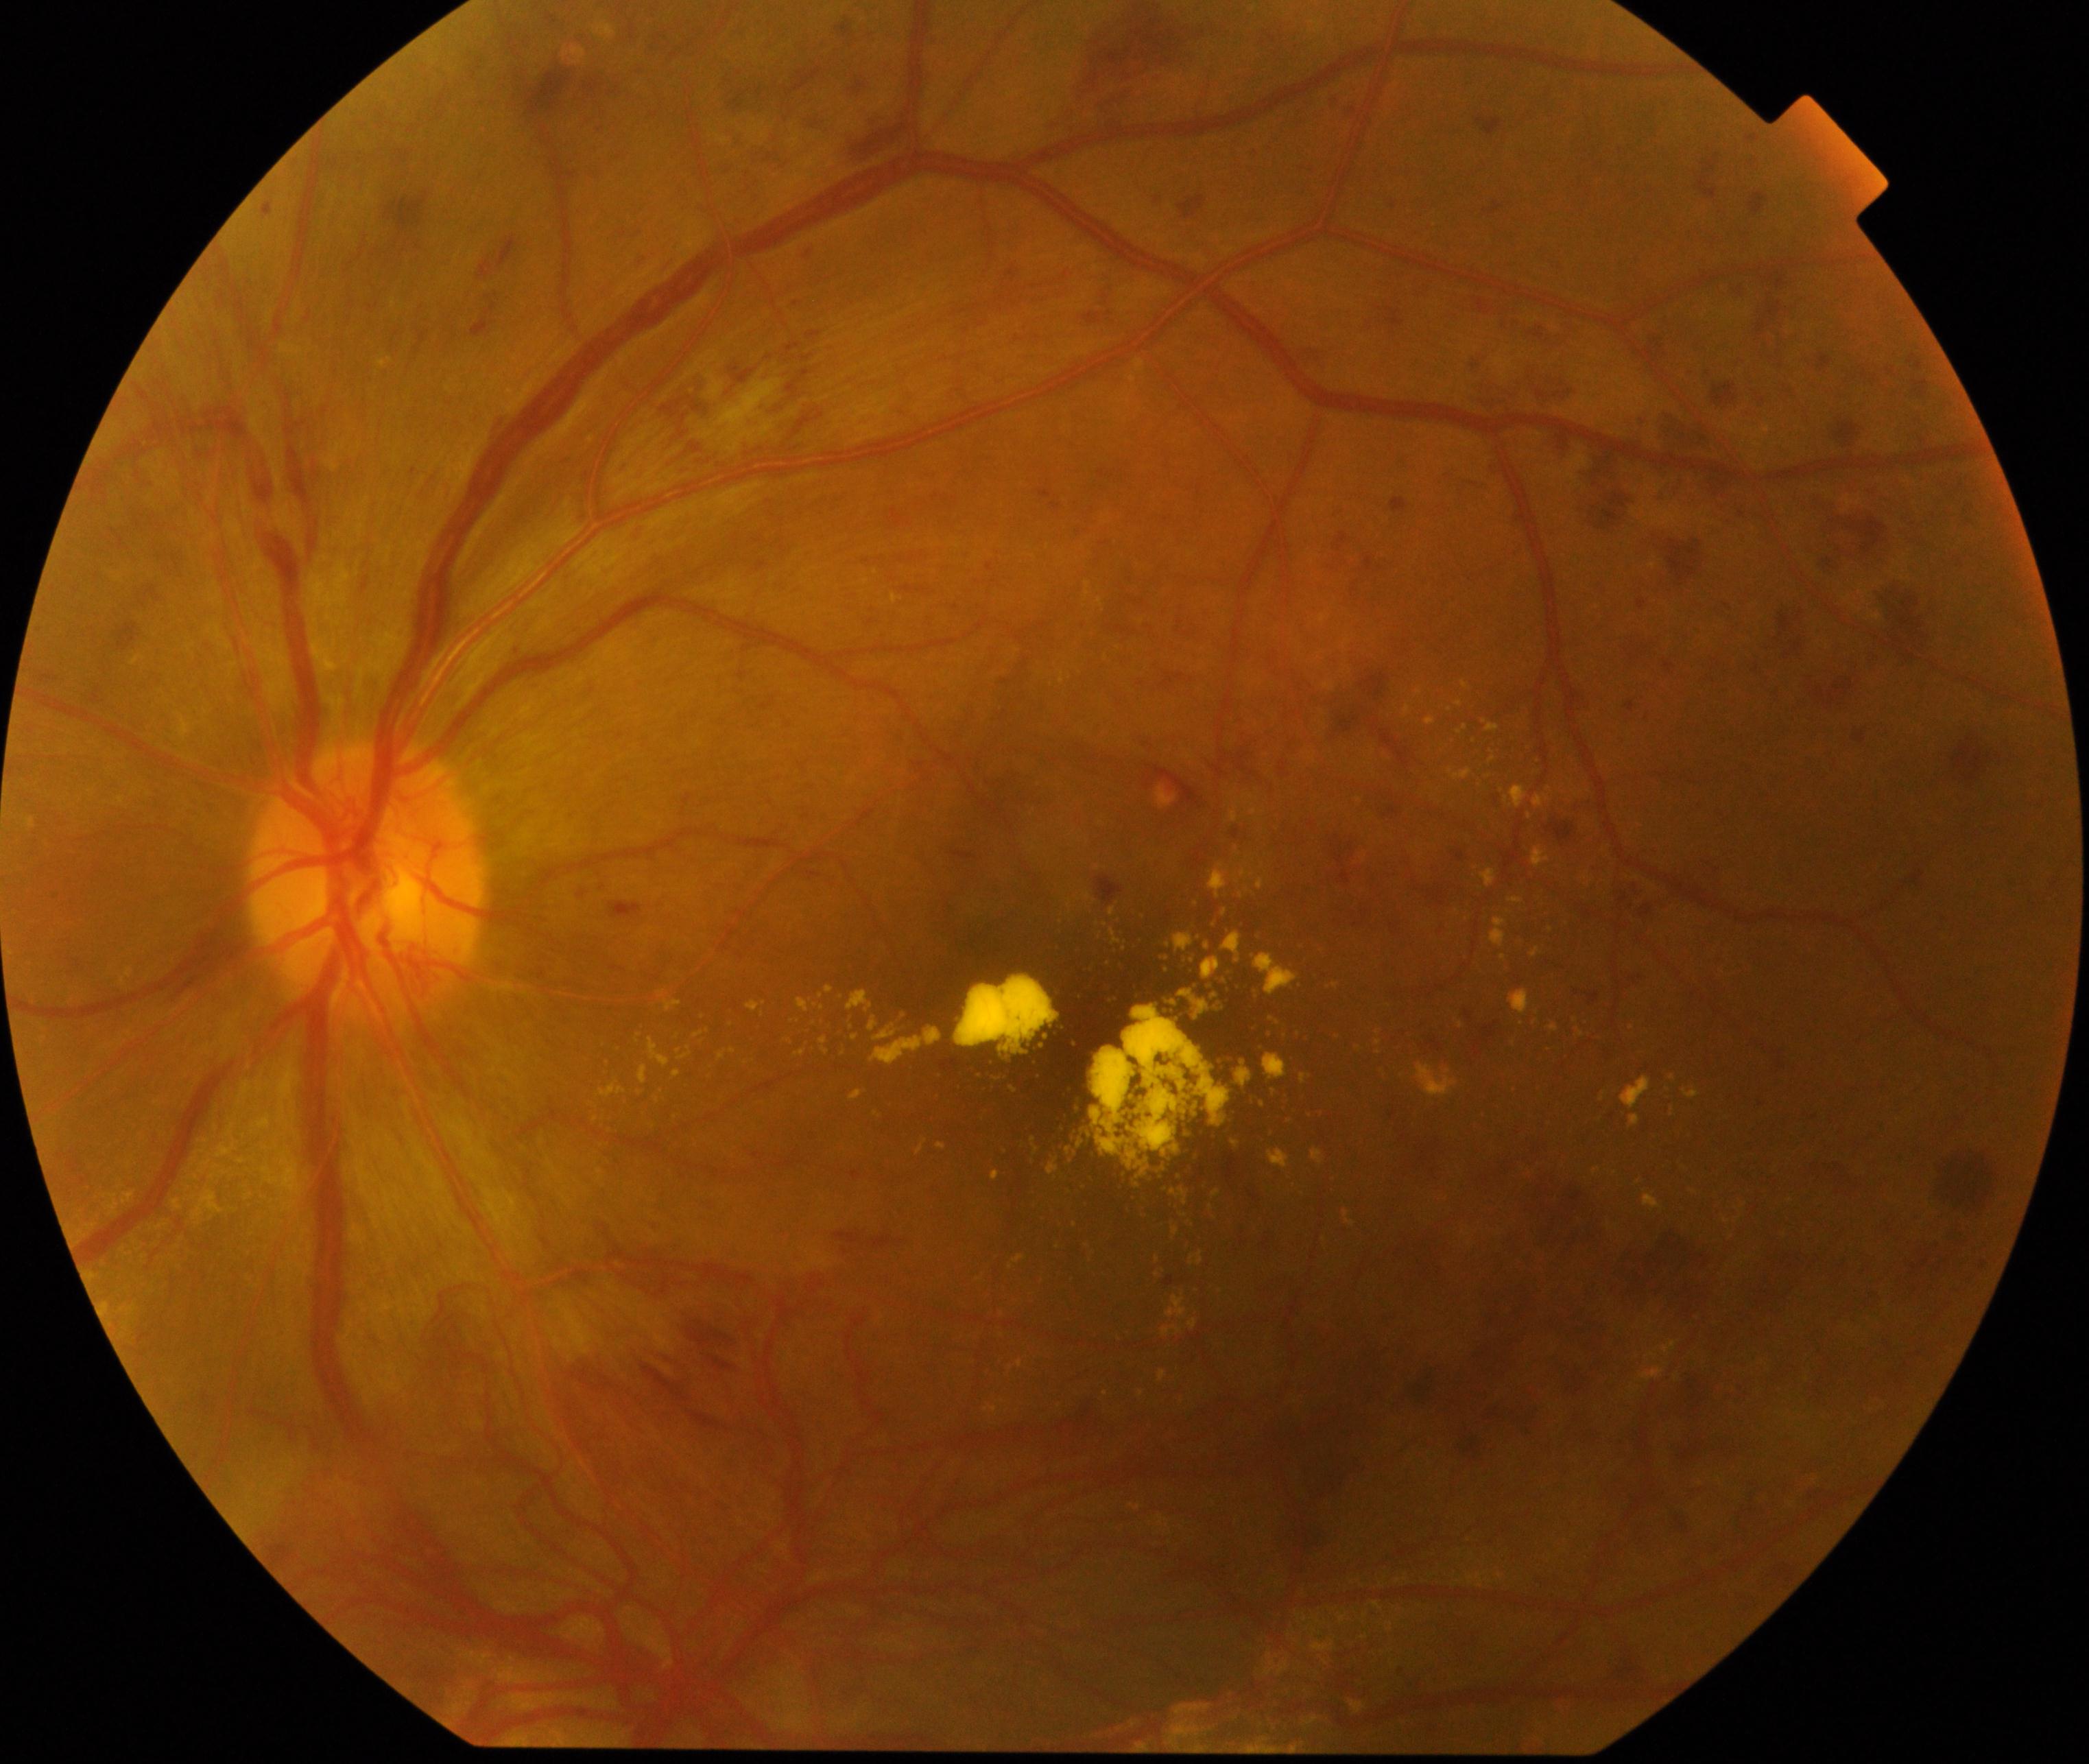
Fundus appearance consistent with severe non-proliferative or proliferative diabetic retinopathy.